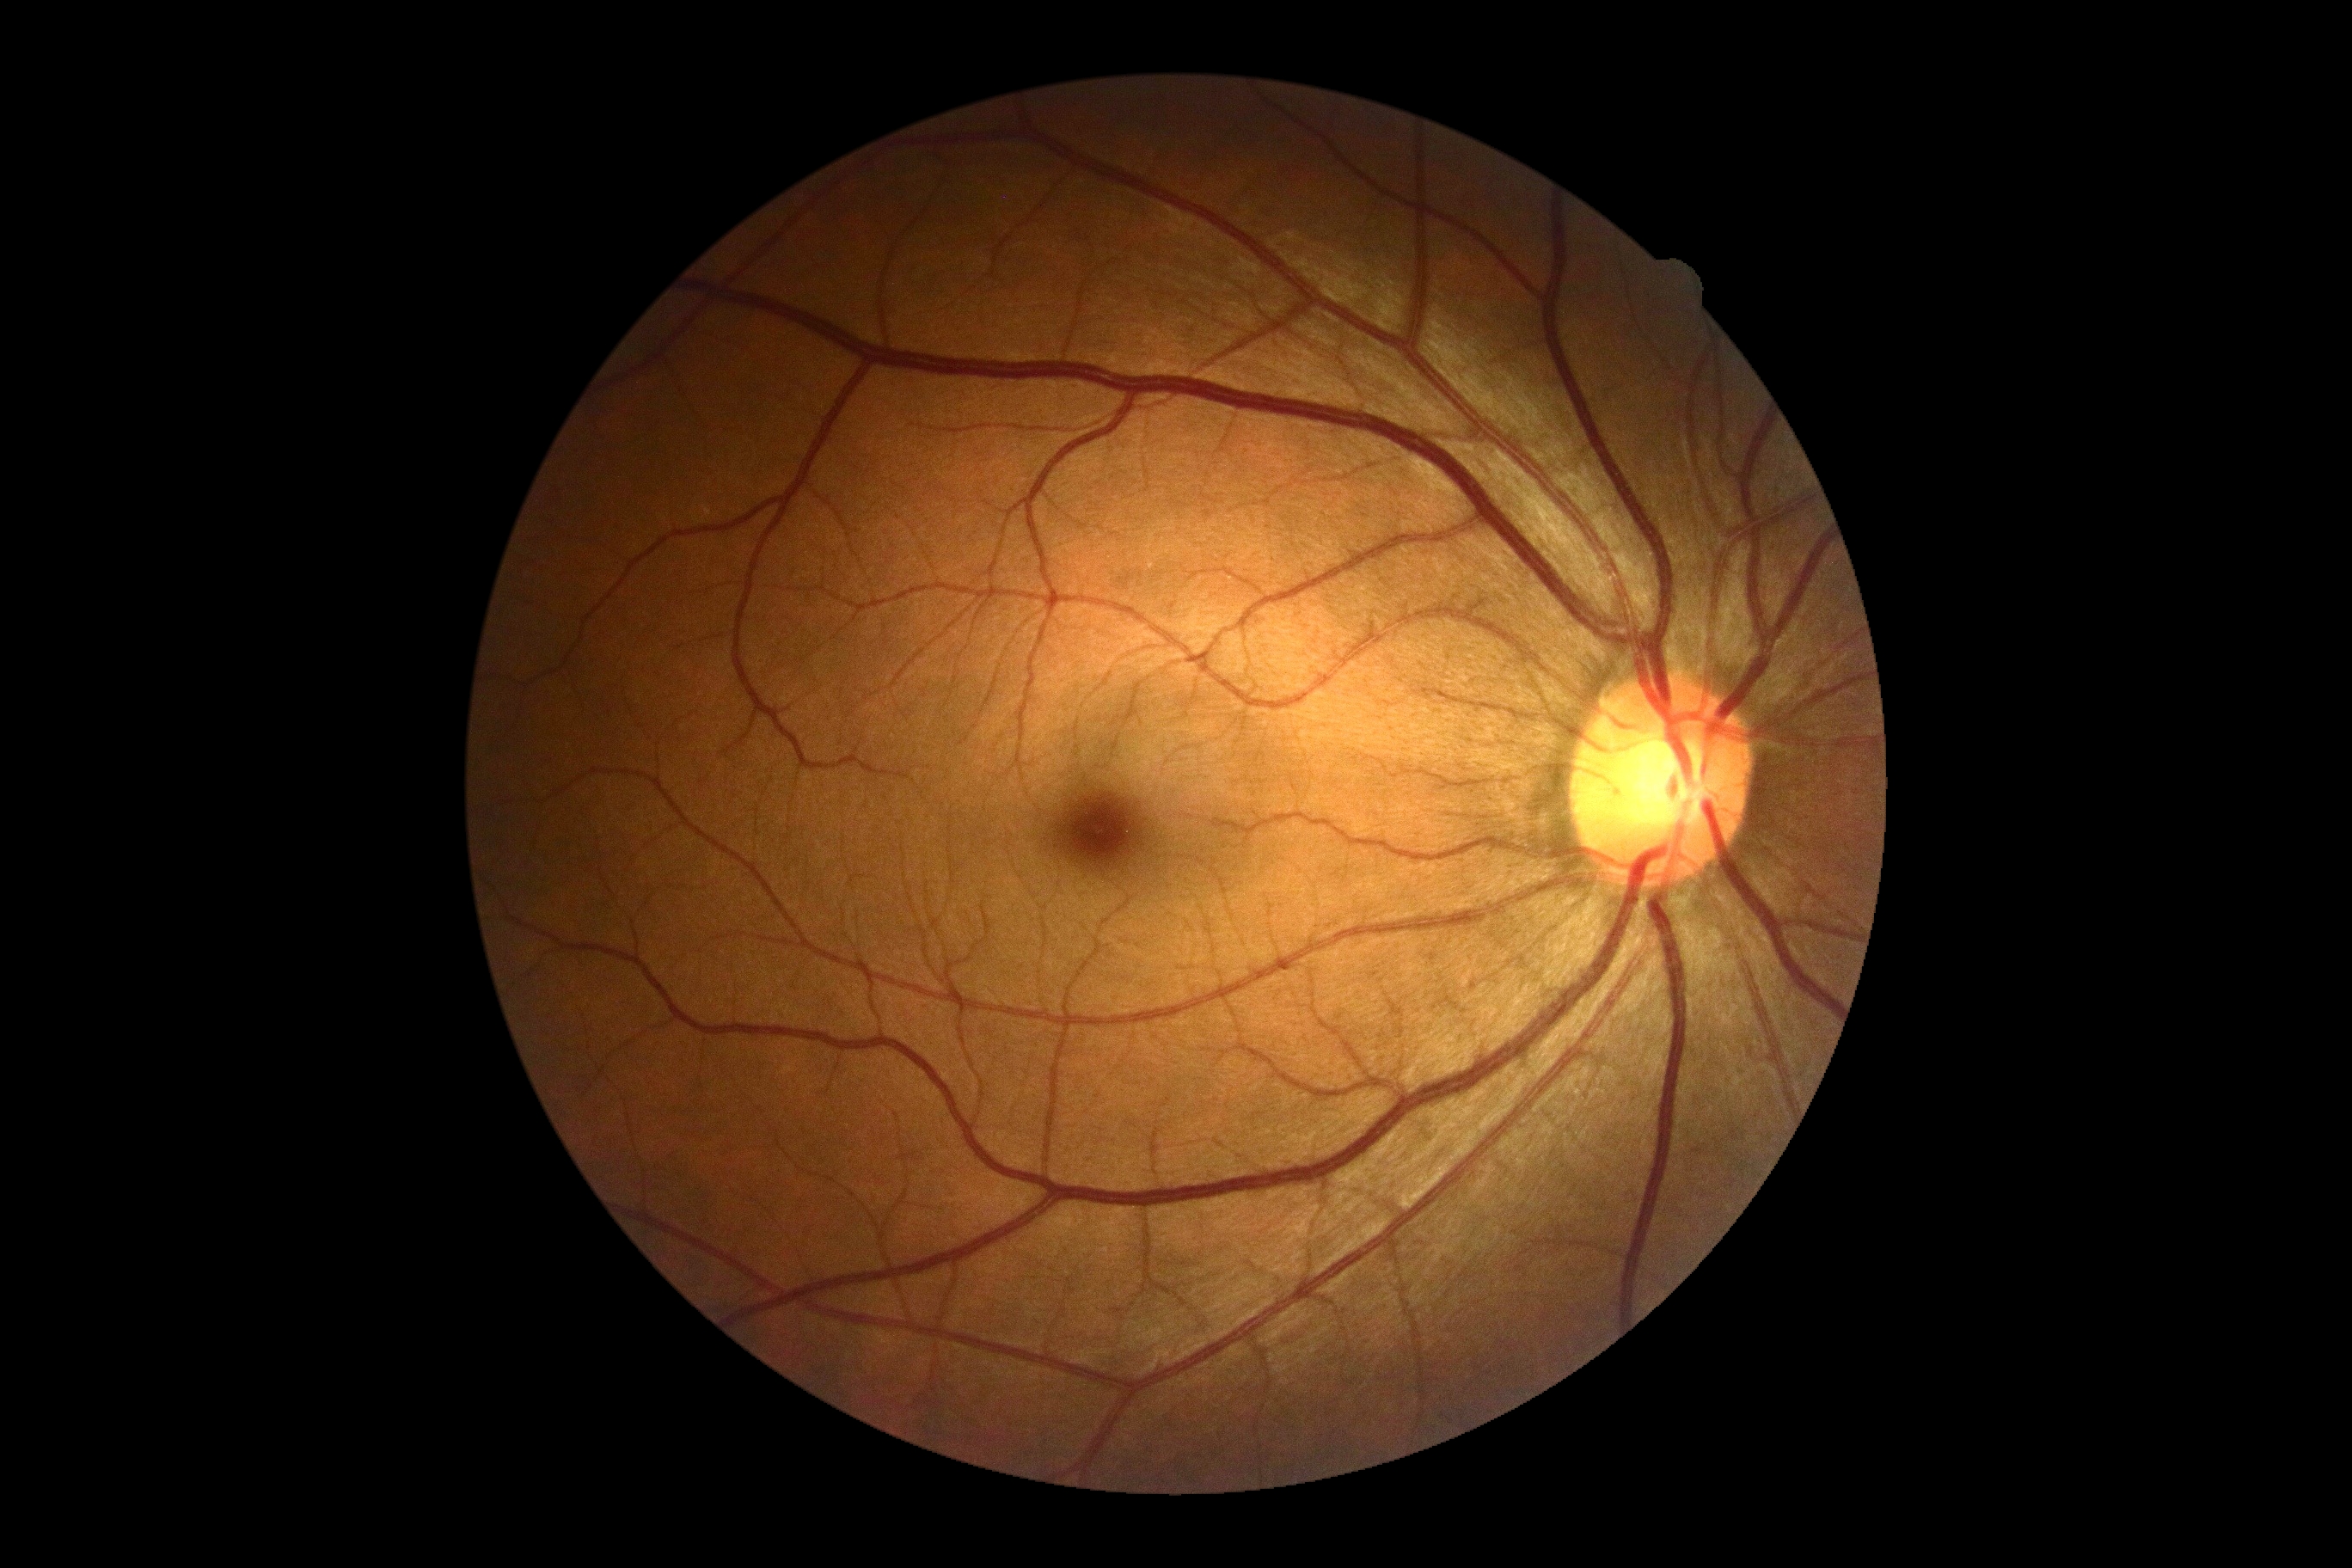

DR severity is grade 0 (no apparent retinopathy) — no visible signs of diabetic retinopathy.